ONH-centered crop from a color fundus image: 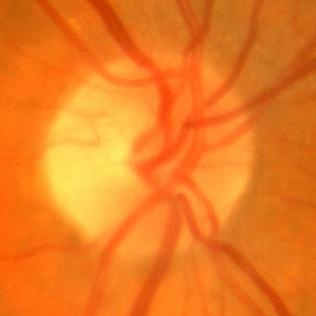

Q: Is glaucoma present?
A: No evidence of glaucoma.